45° field of view — 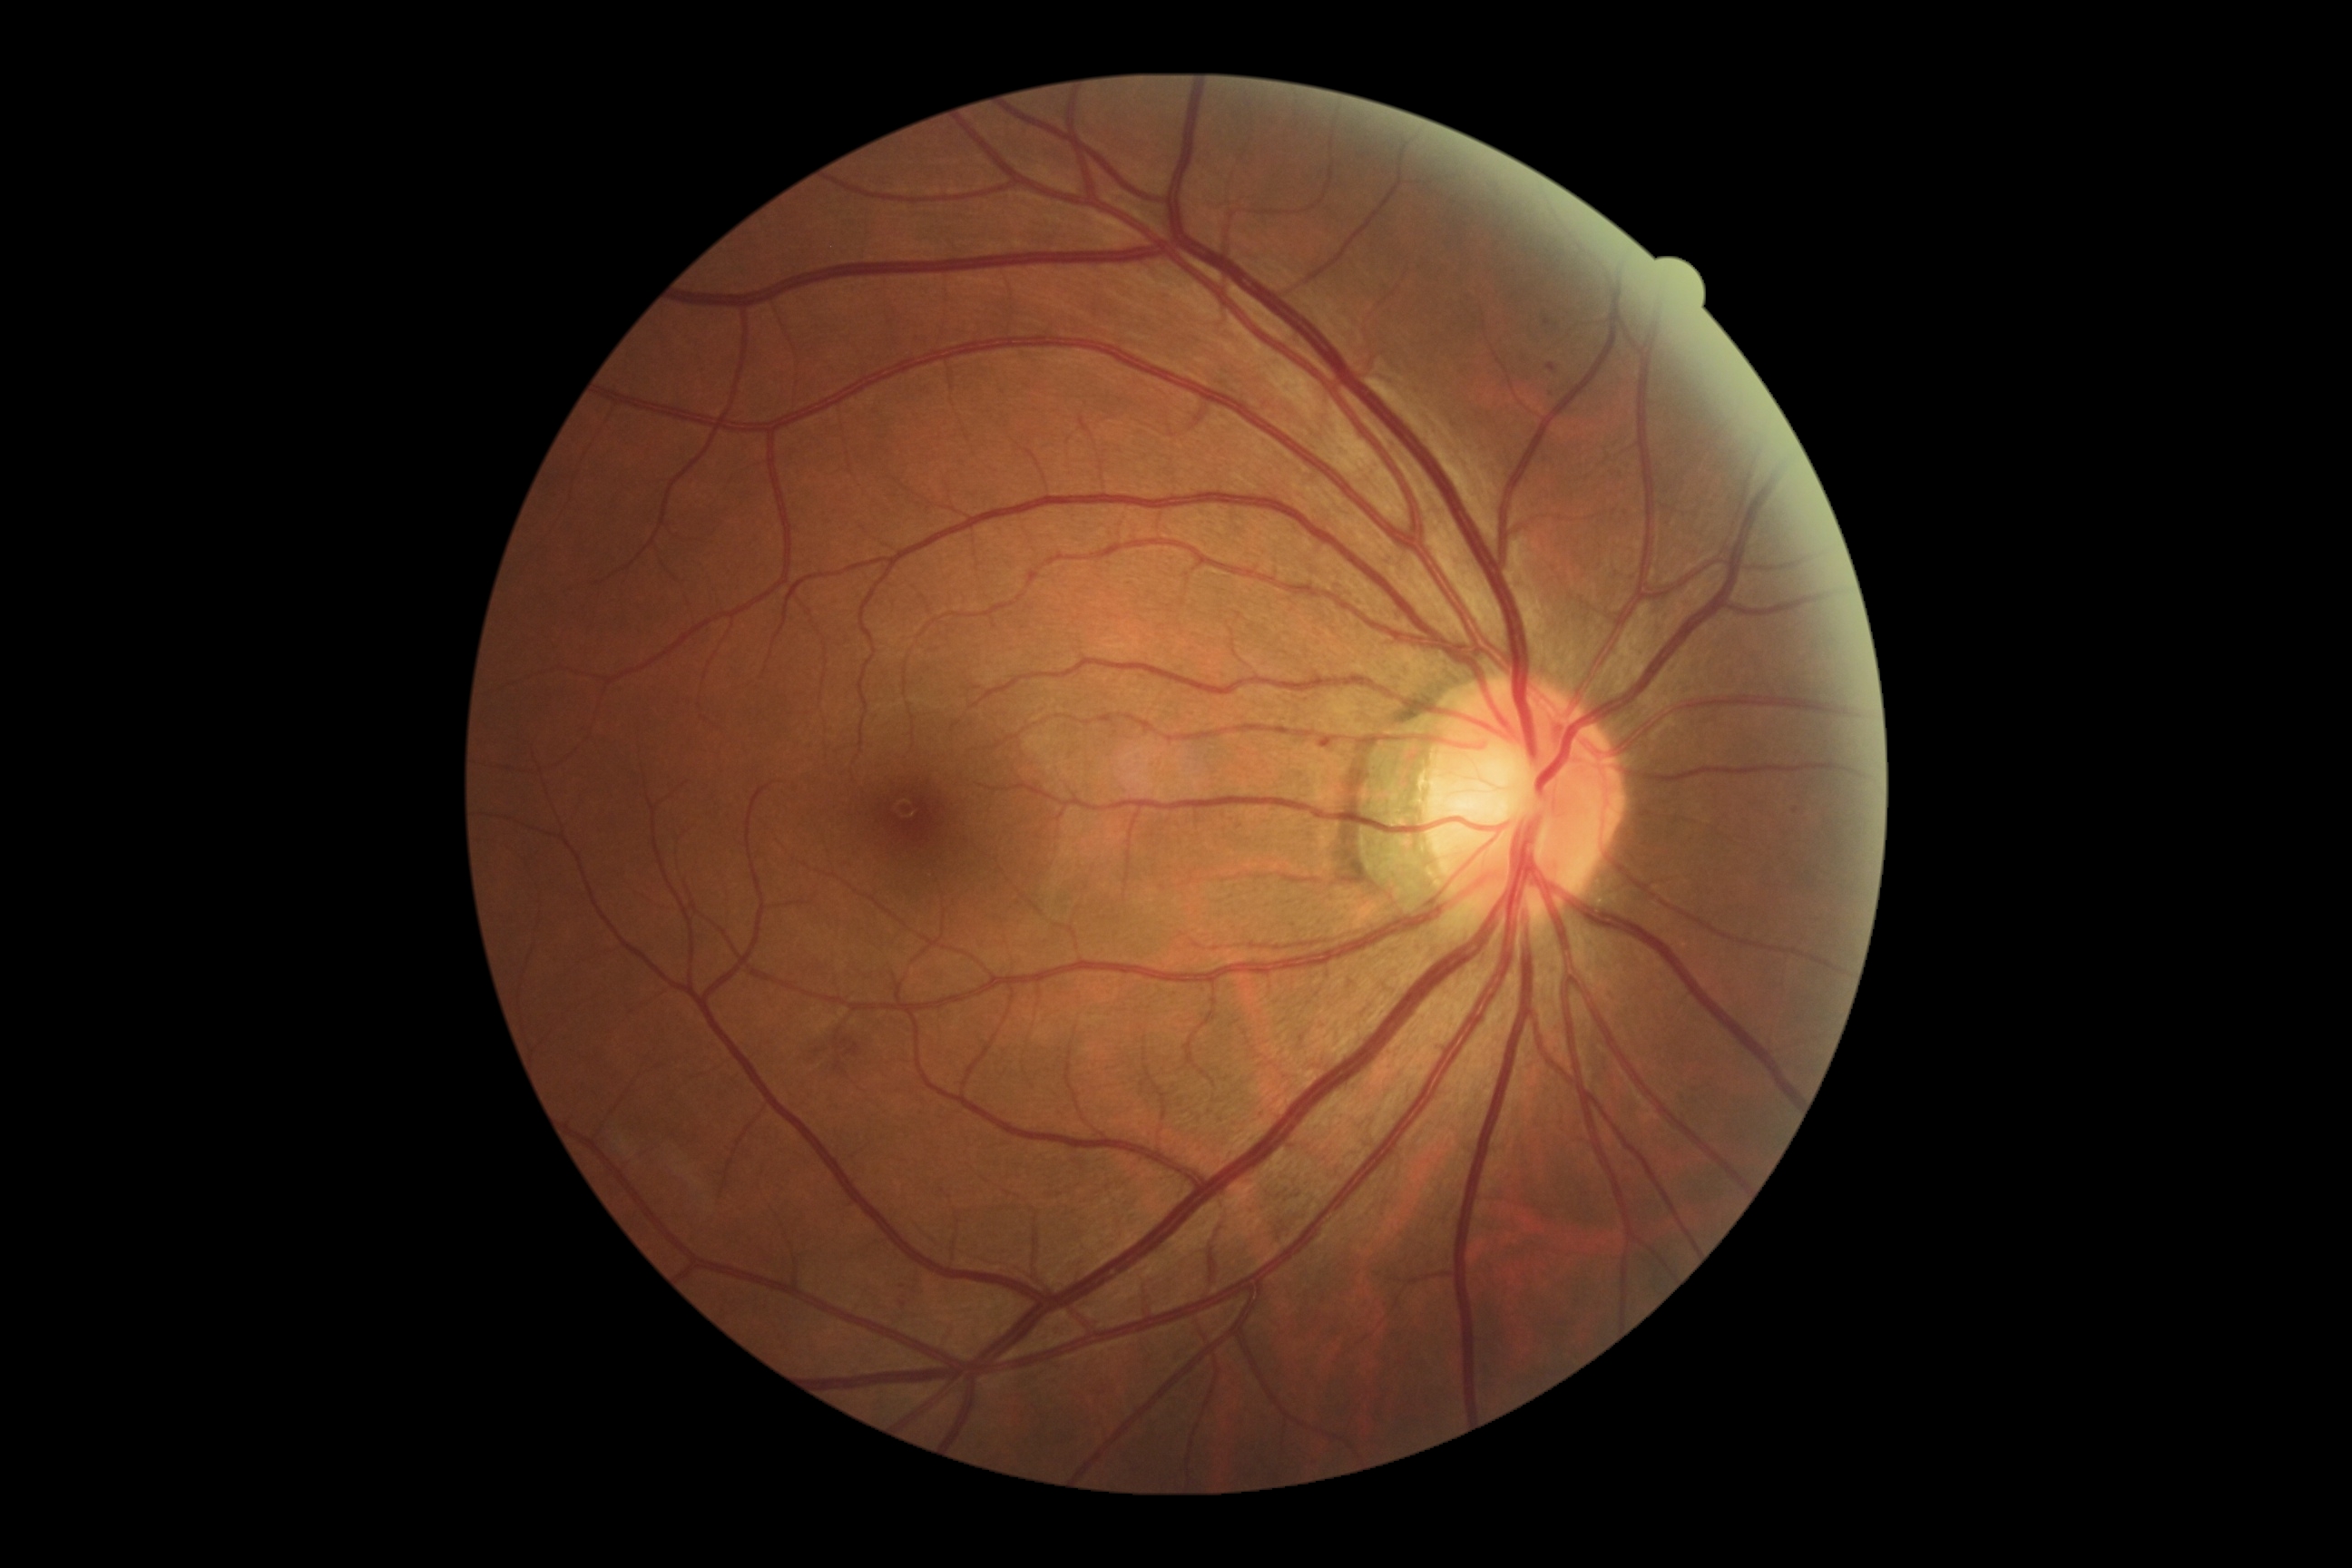

dr_grade: 2
lesions:
  ex: []
  se: []
  ma:
    - 1549,387,1556,397
    - 1547,364,1556,373
    - 1320,740,1331,747
  ma_small_centers:
    - 1548/323
    - 1796/811
    - 903/1287
    - 903/1305
  he:
    - 847,1044,861,1057
  he_small_centers:
    - 817/1052
    - 838/1066
    - 844/1042